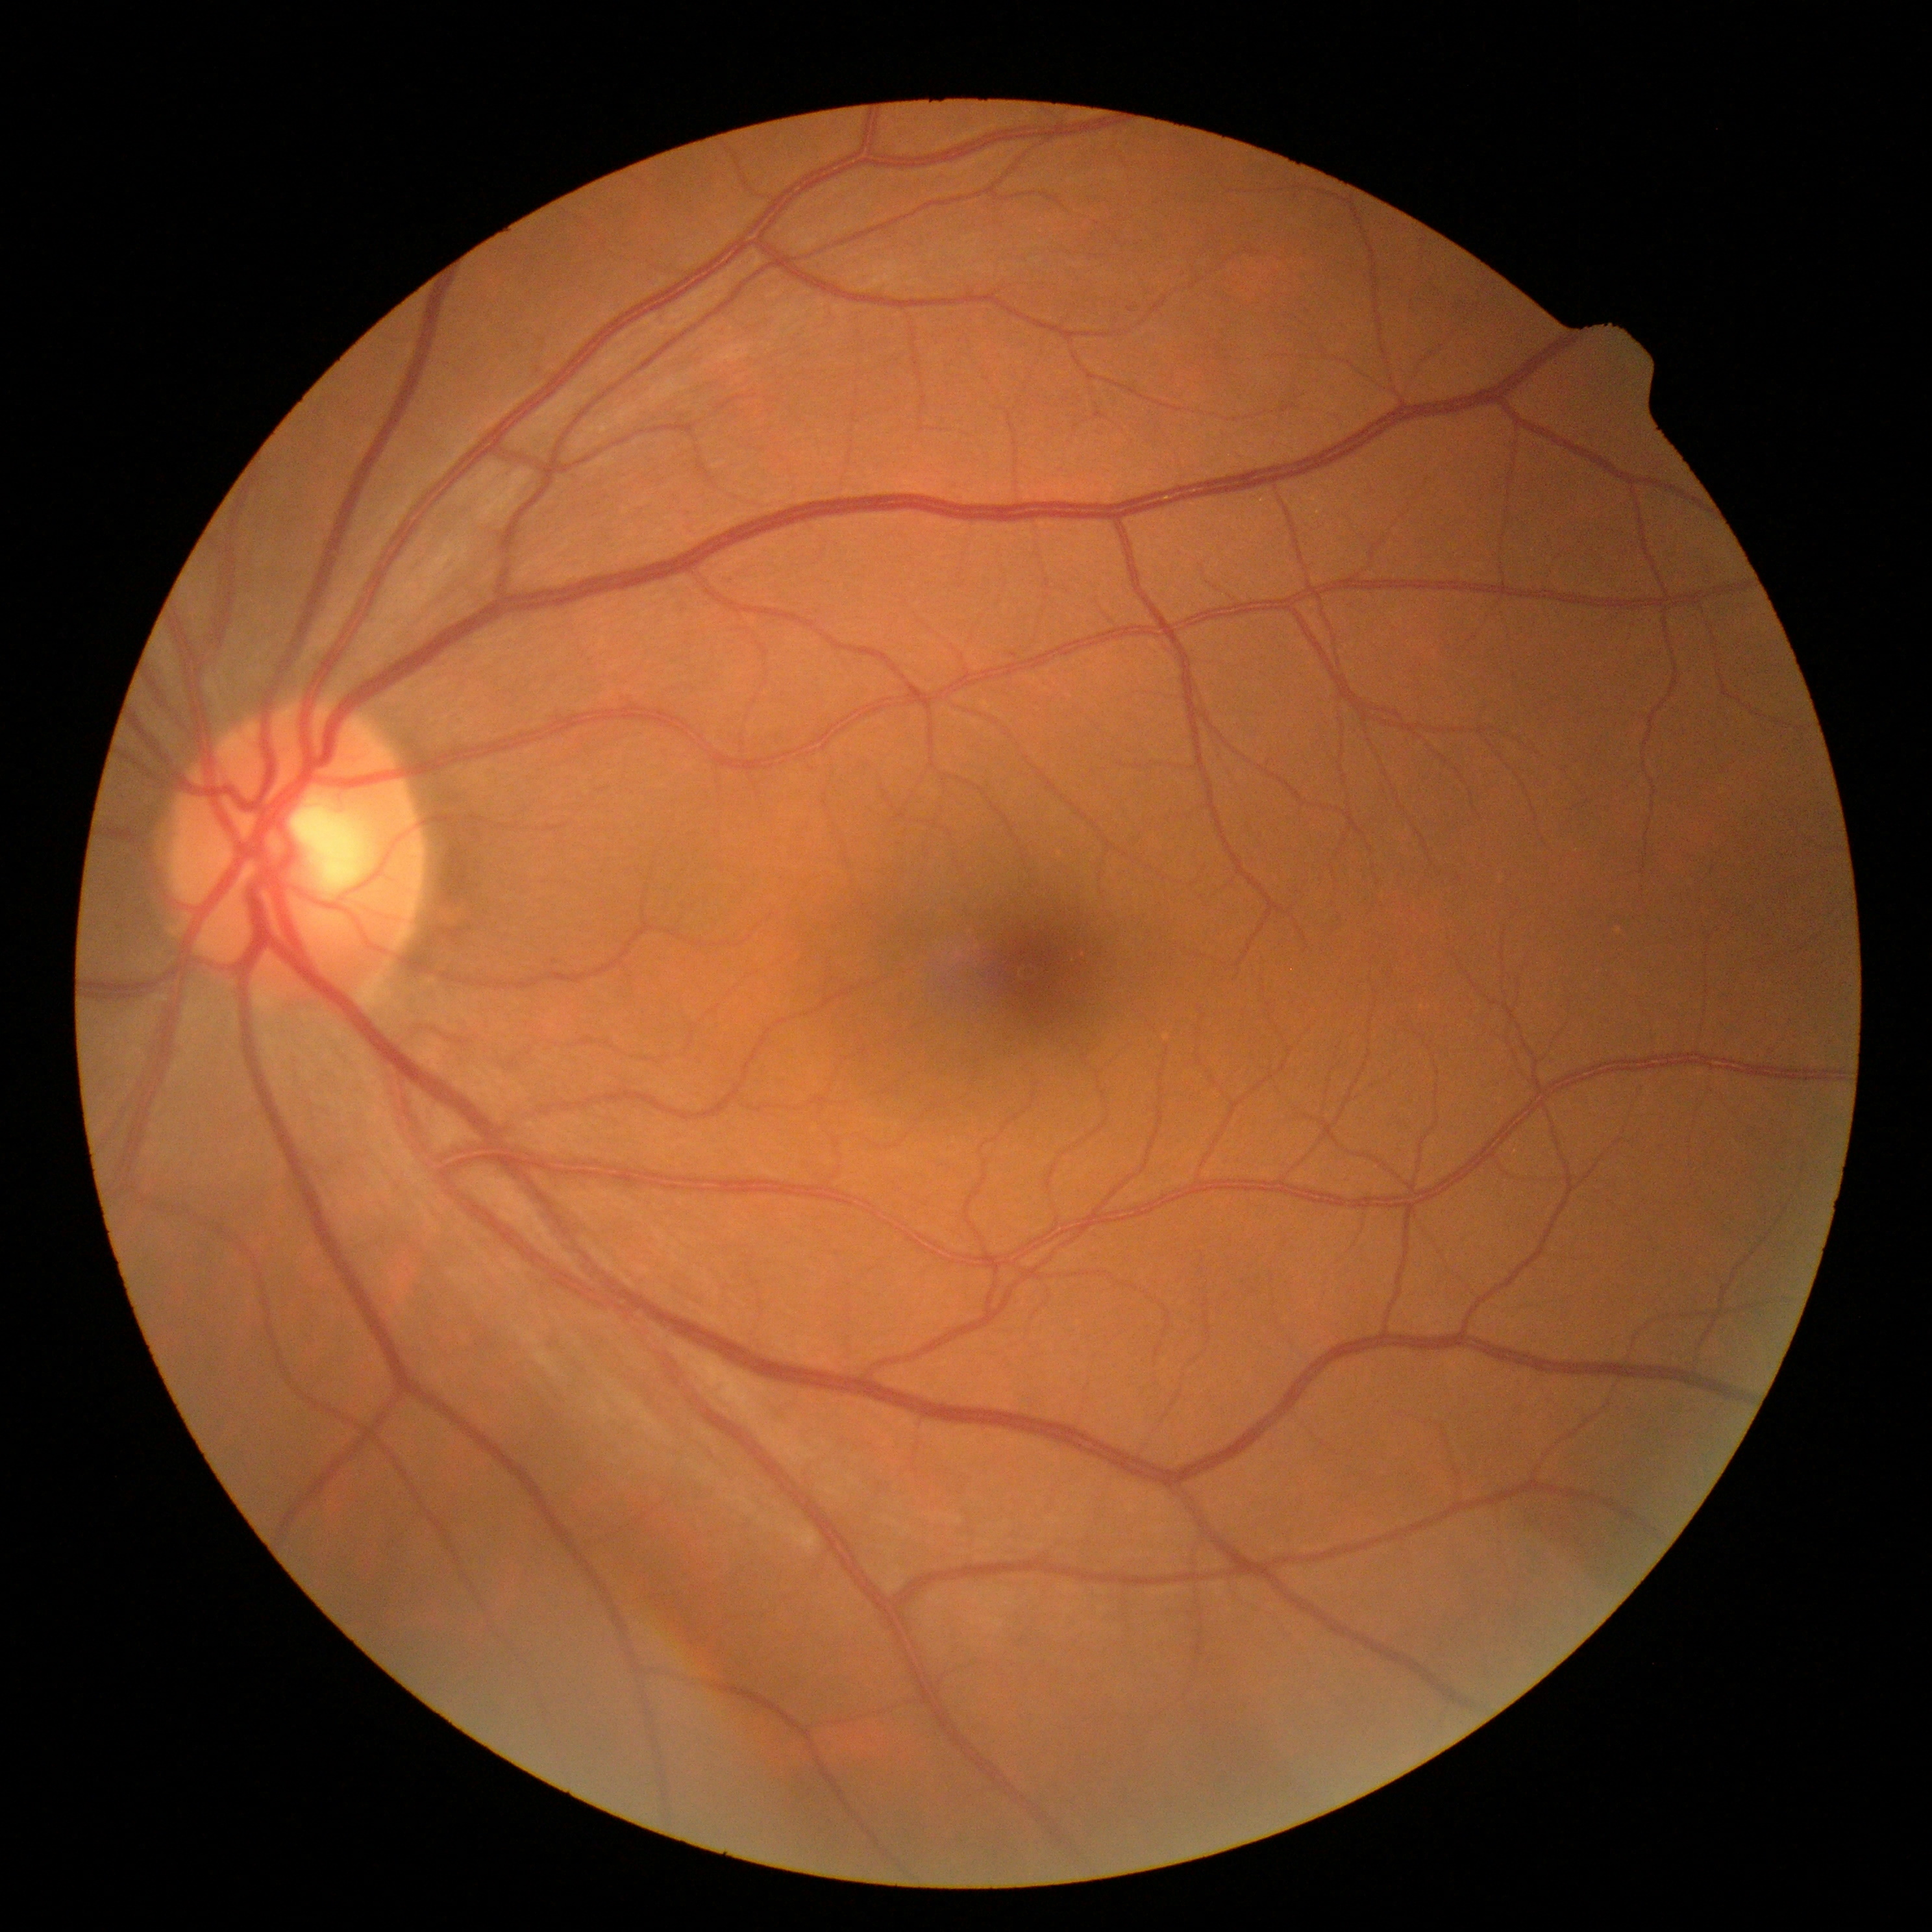

DR grade=no apparent retinopathy (0), DR impression=no signs of DR.